2048 x 1536 pixels, FOV: 45 degrees: 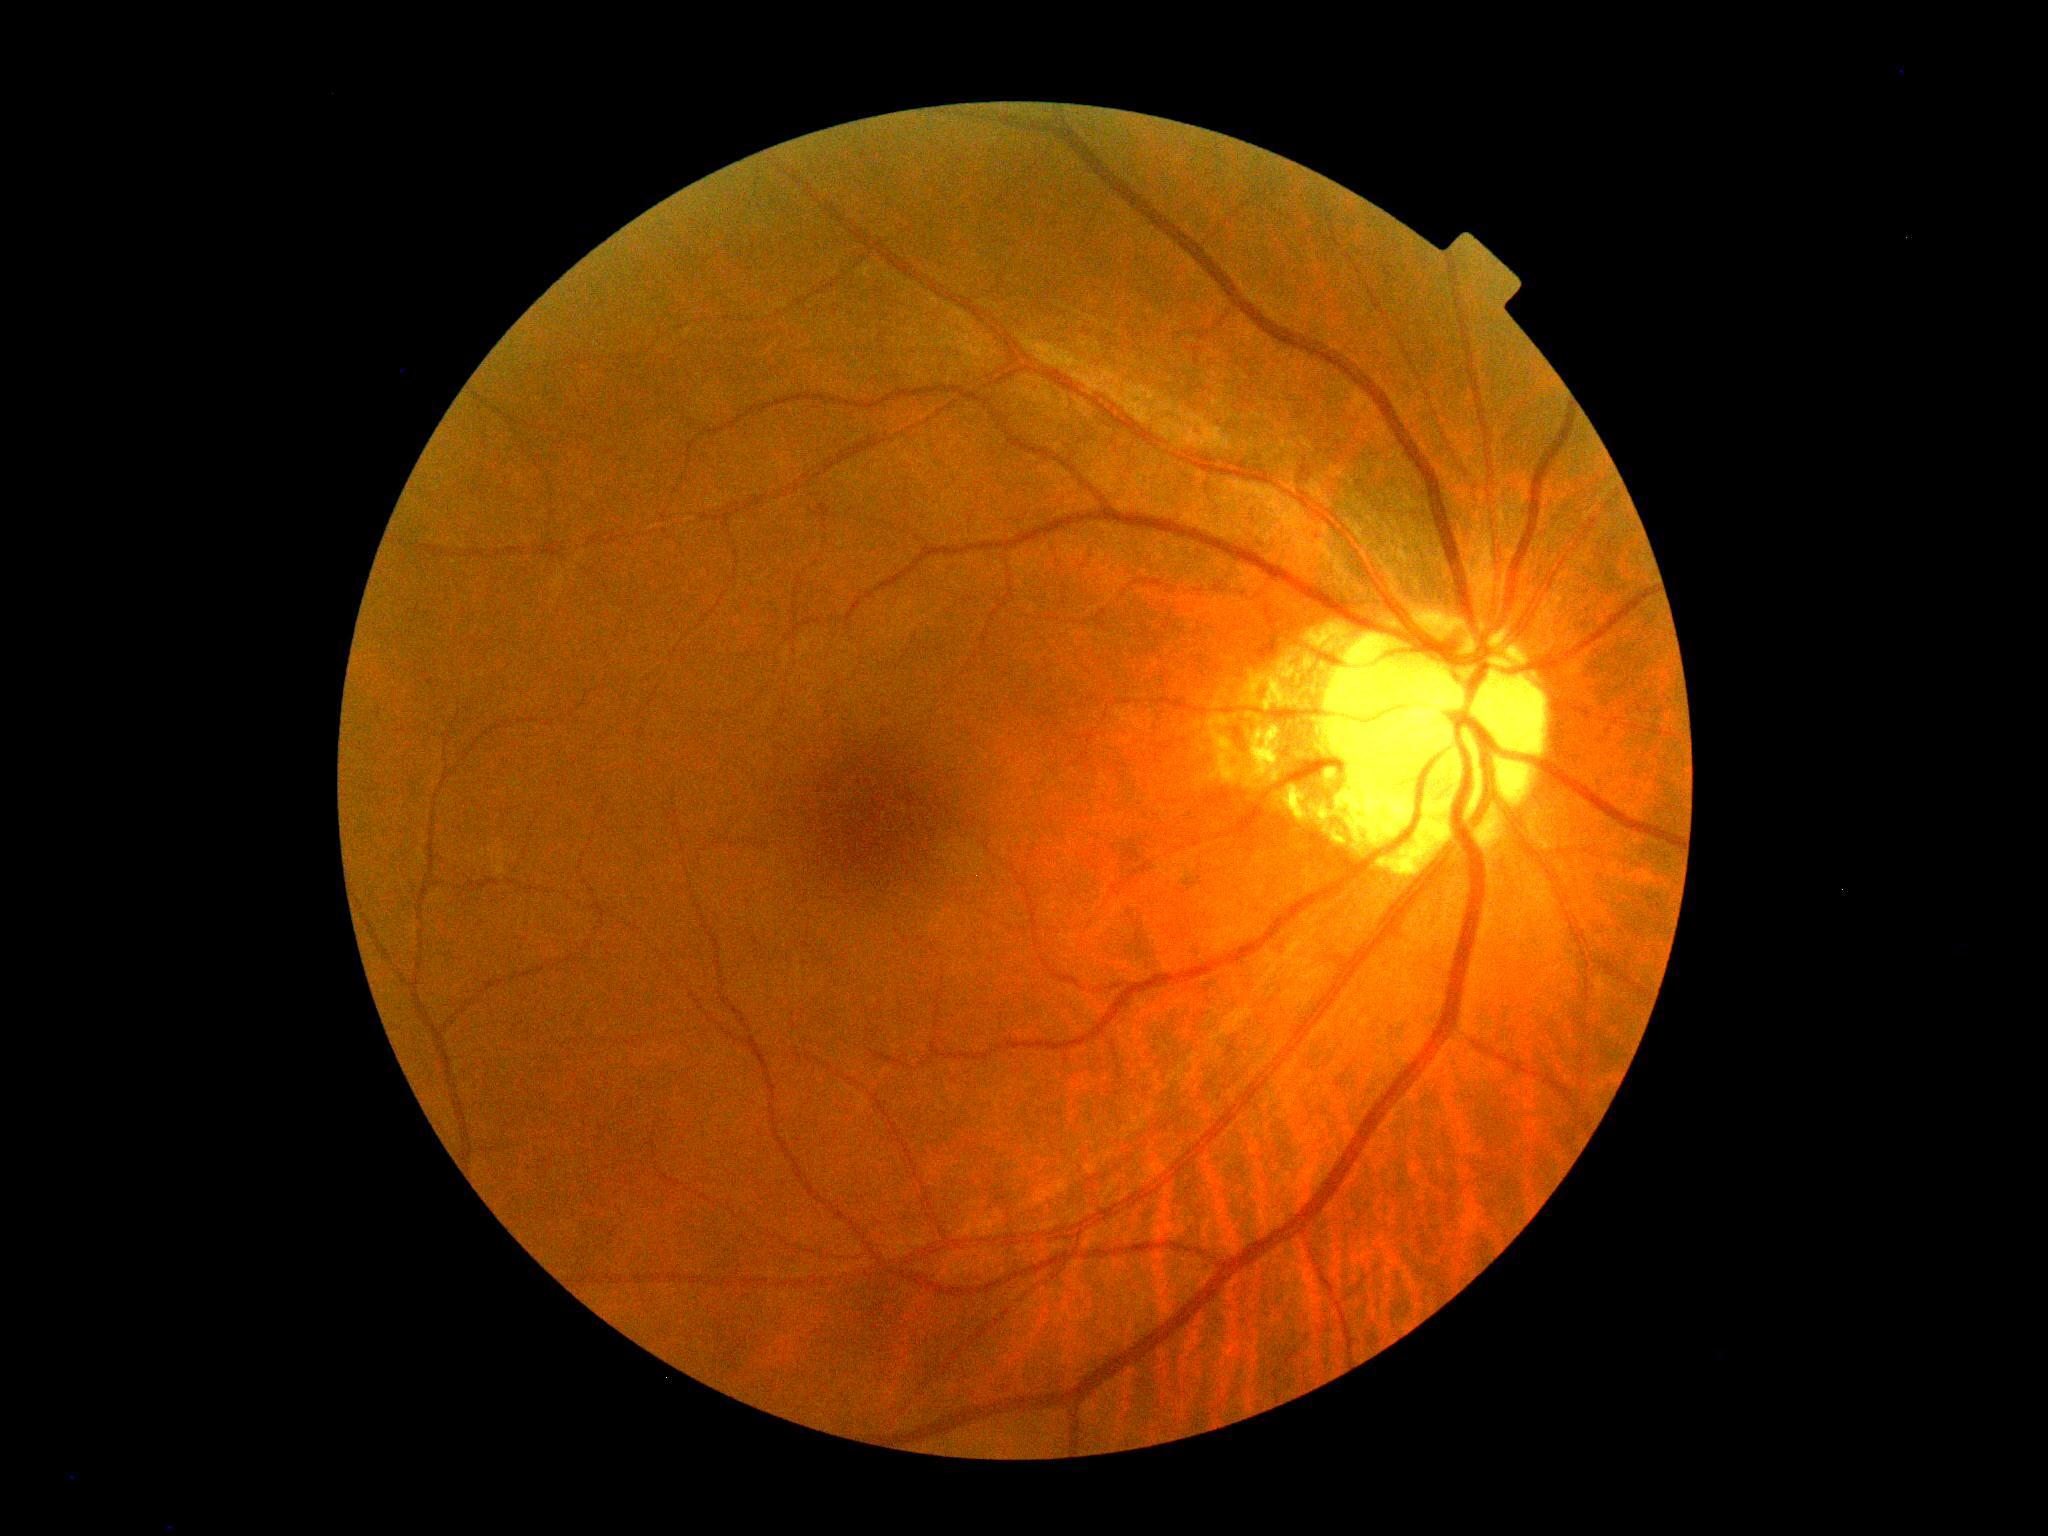
Diabetic retinopathy (DR) is 0/4.